Modified Davis grading. 848x848 — 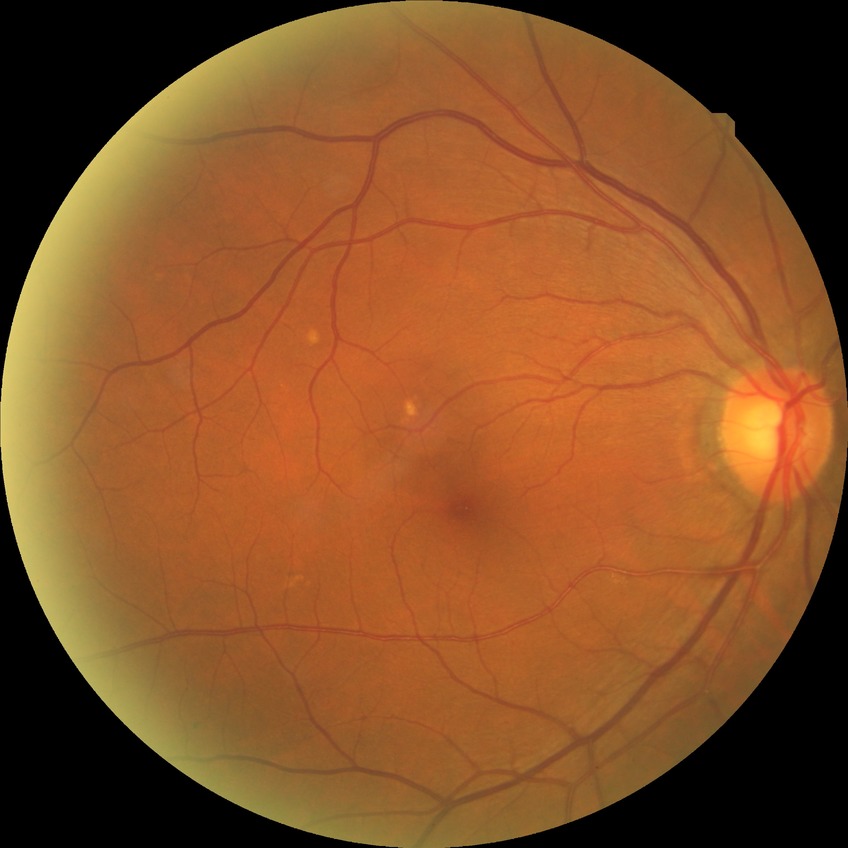

{"dr_impression": "negative for DR", "davis_grade": "NDR"}